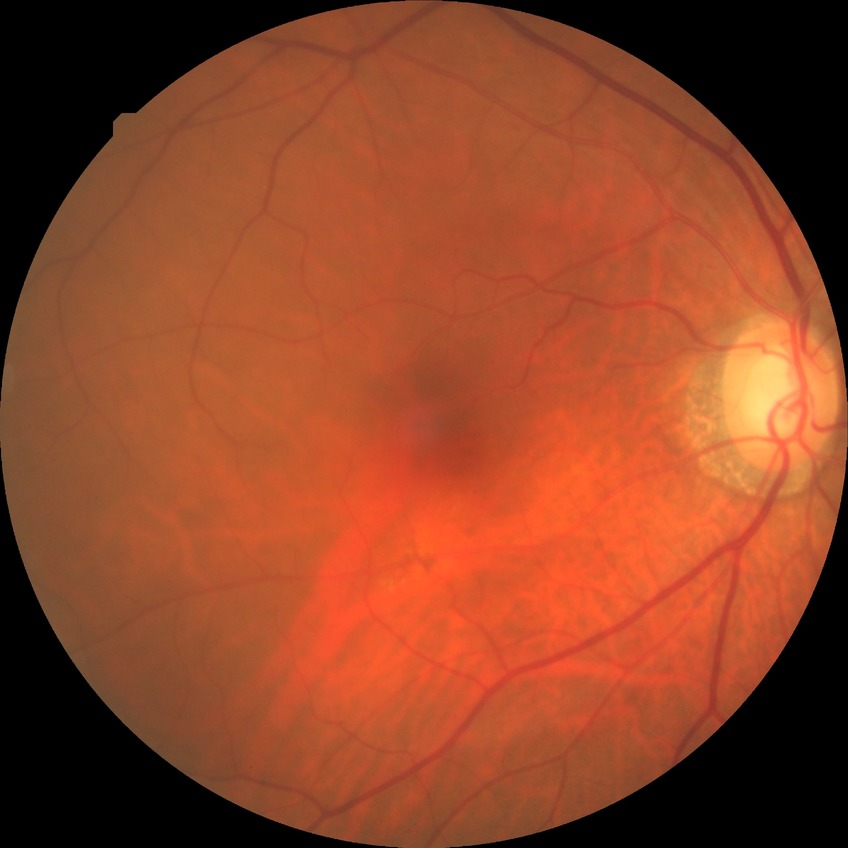 Modified Davis grade: NDR.